Color fundus image · Davis DR grading.
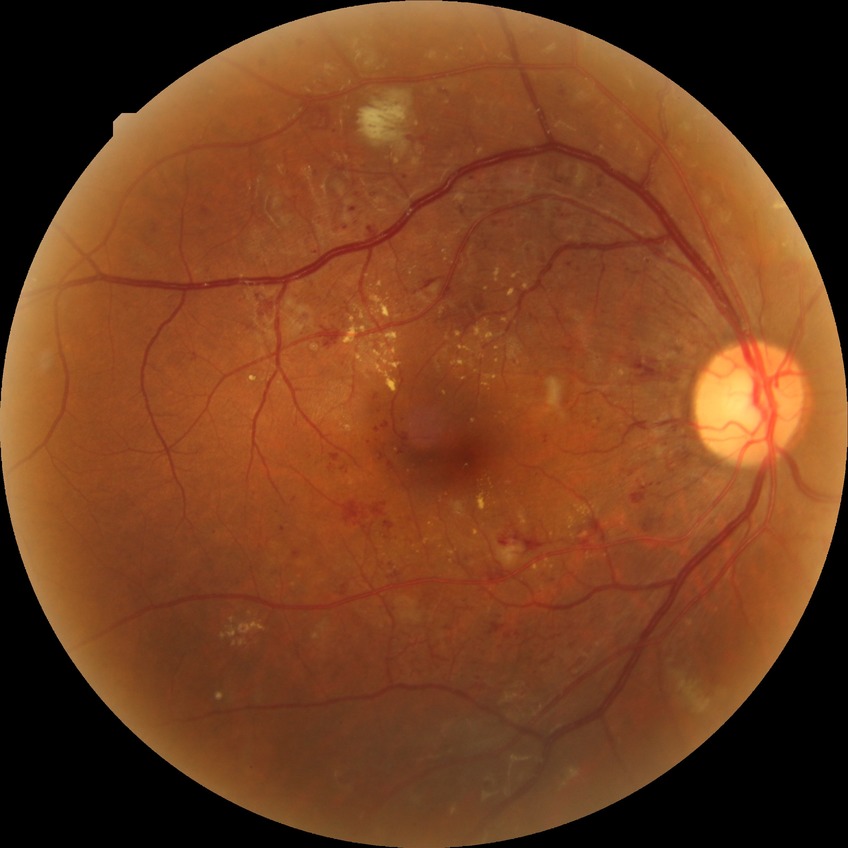 – Davis stage: PDR